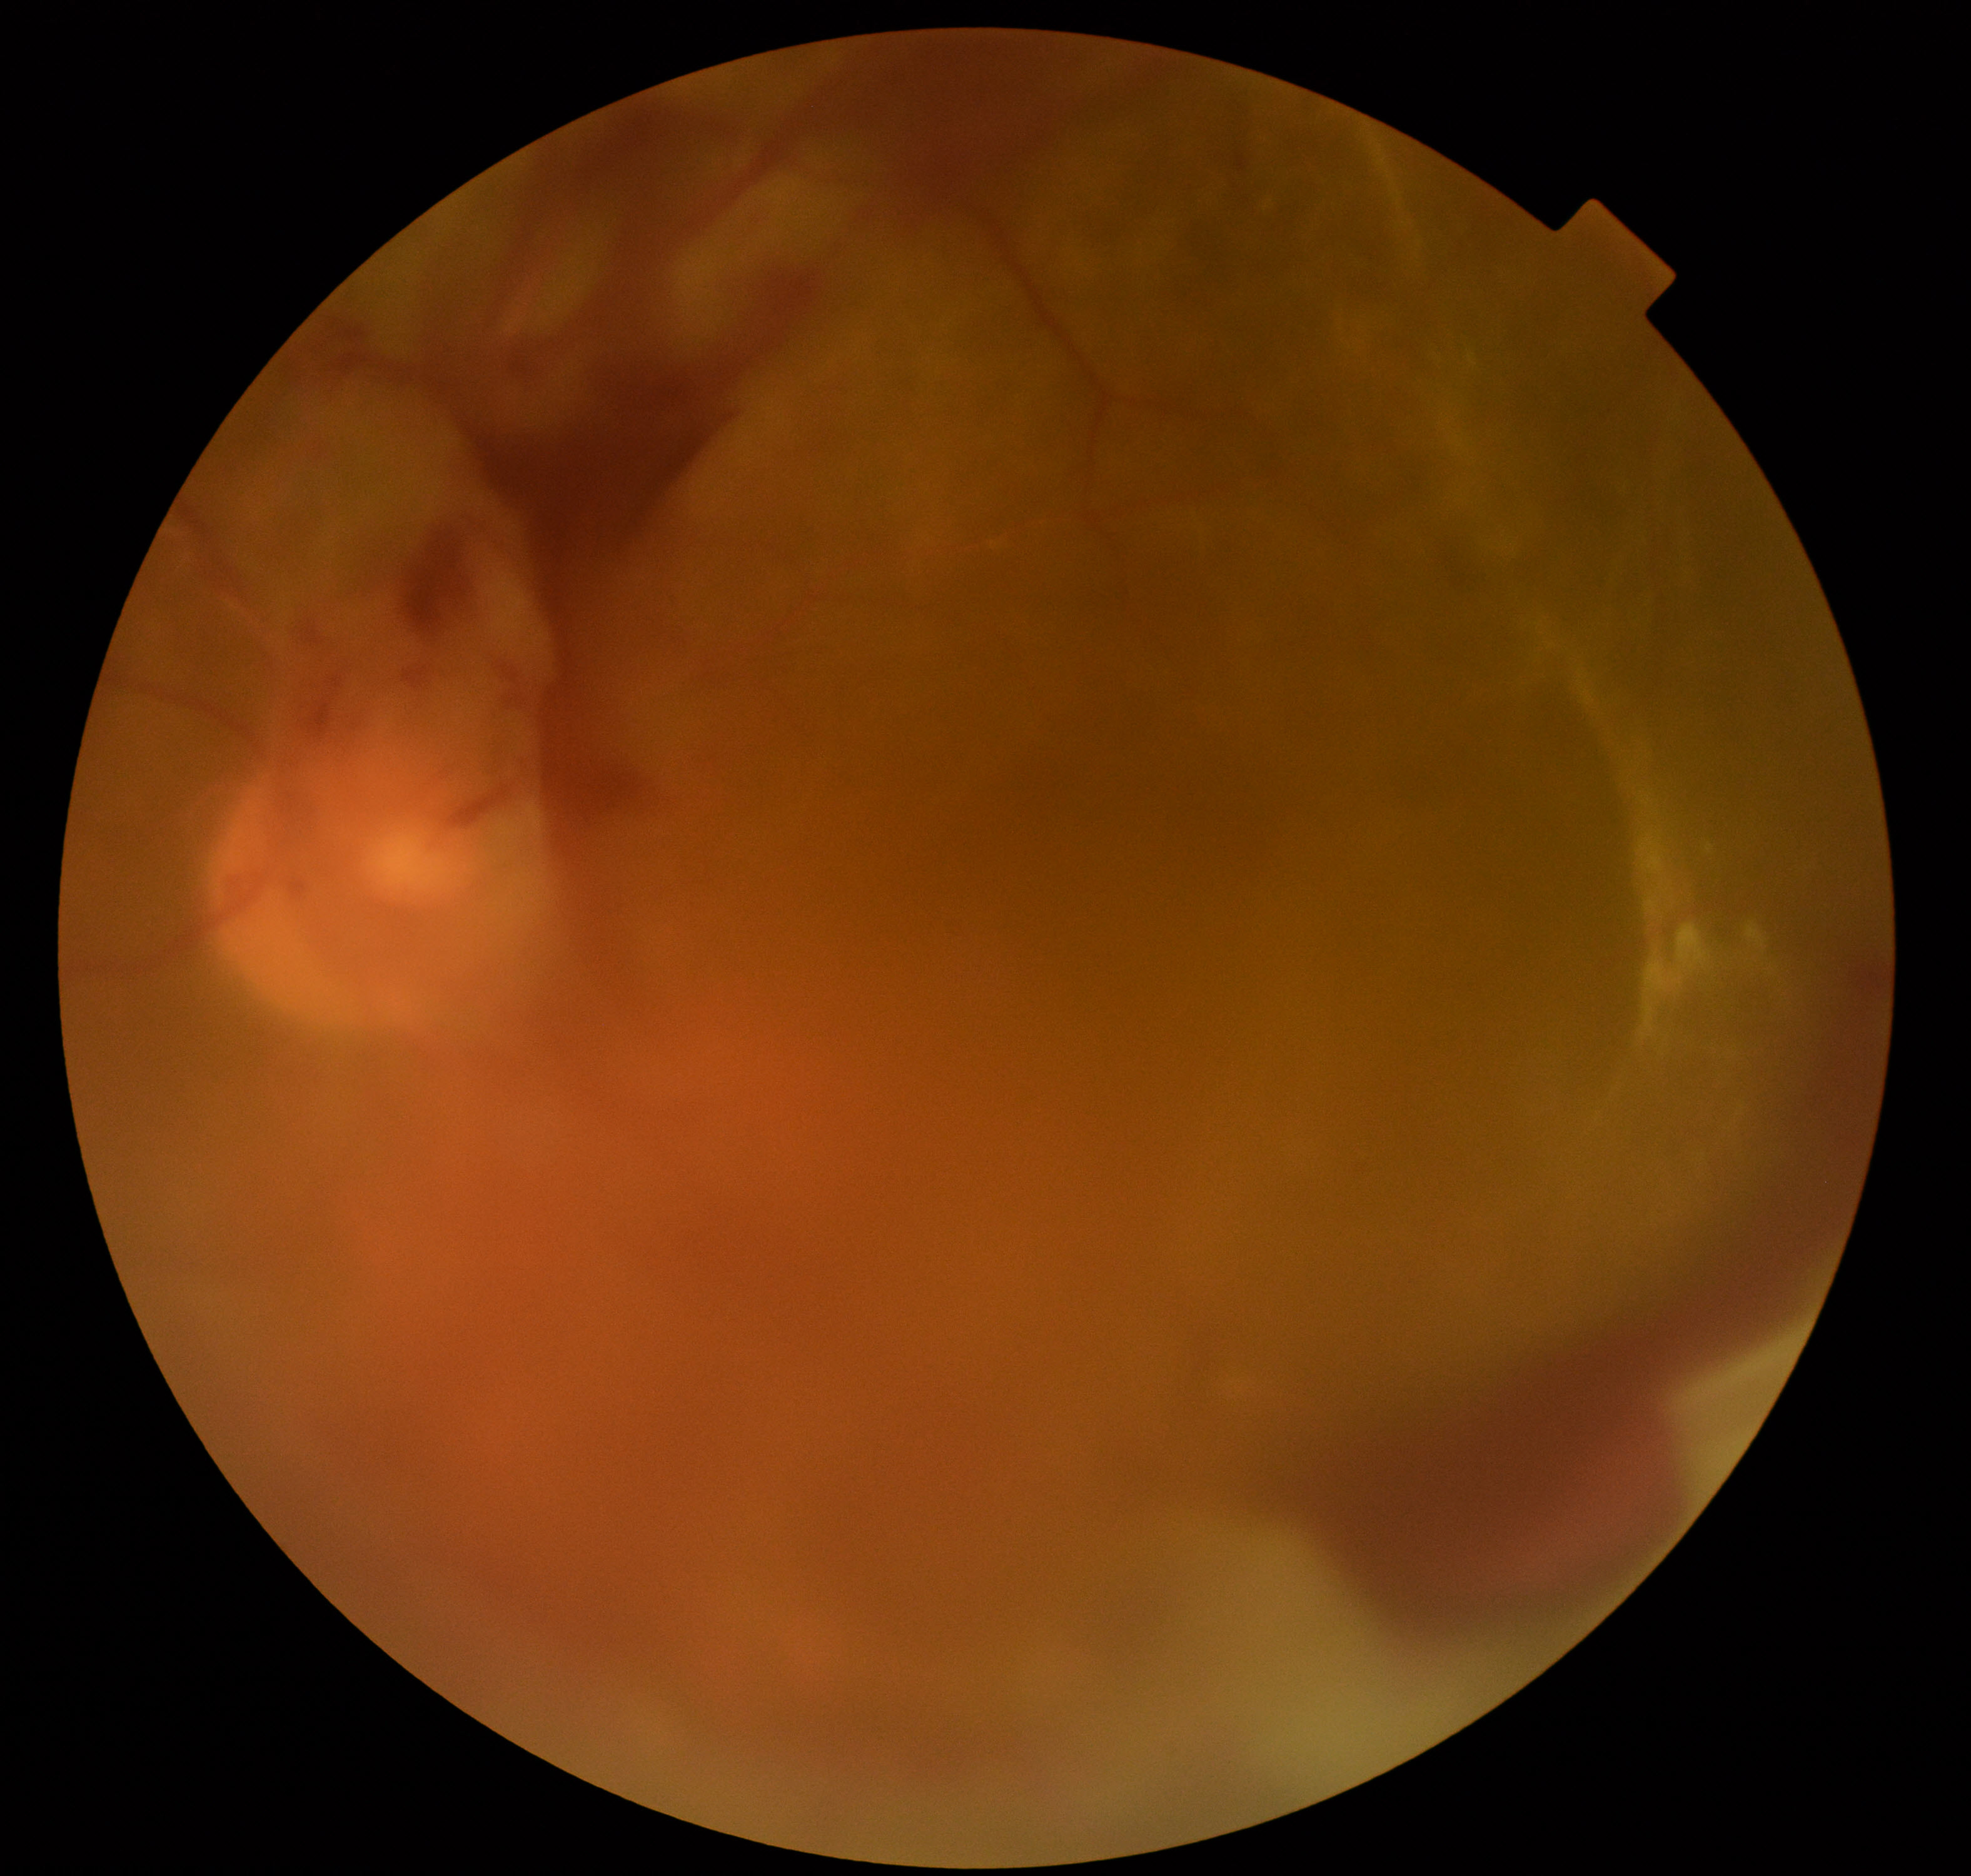
Image quality: blurred, more than half the field obscured.
Proliferative retinopathy: suspected, not confirmed.